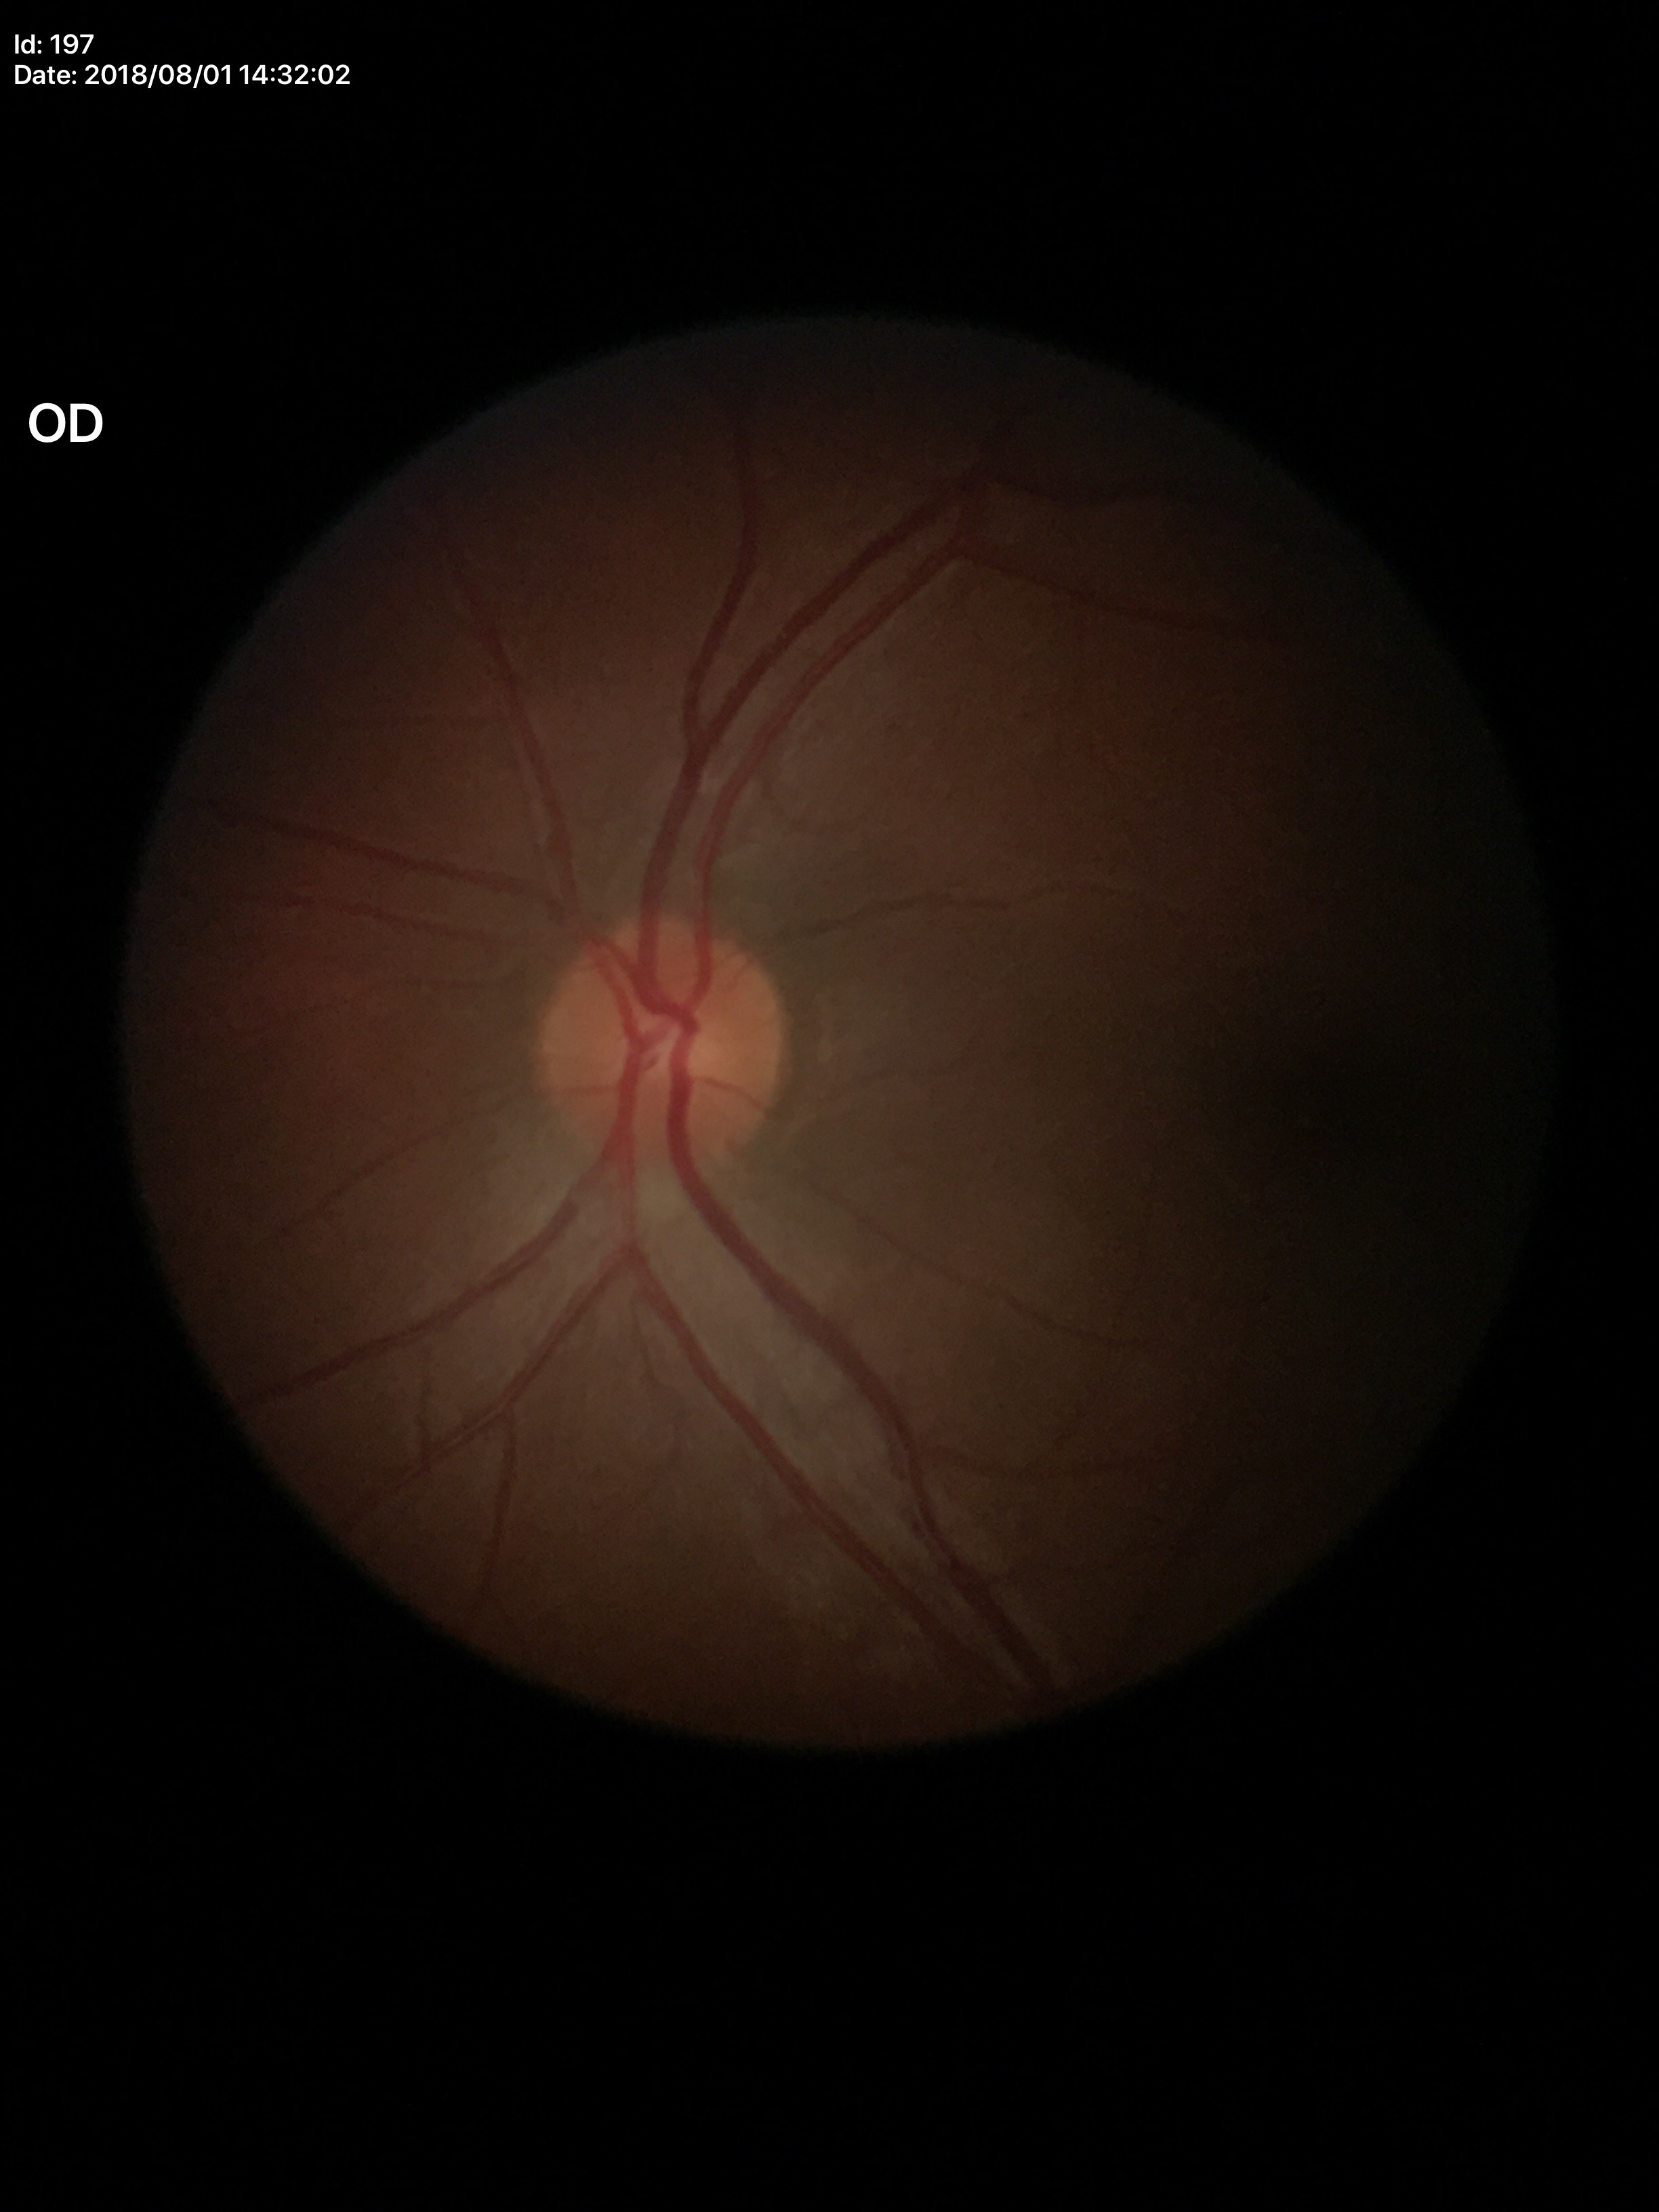

Glaucoma screening impression: not suspect.
VCDR is 0.39.
ACDR is 0.19.